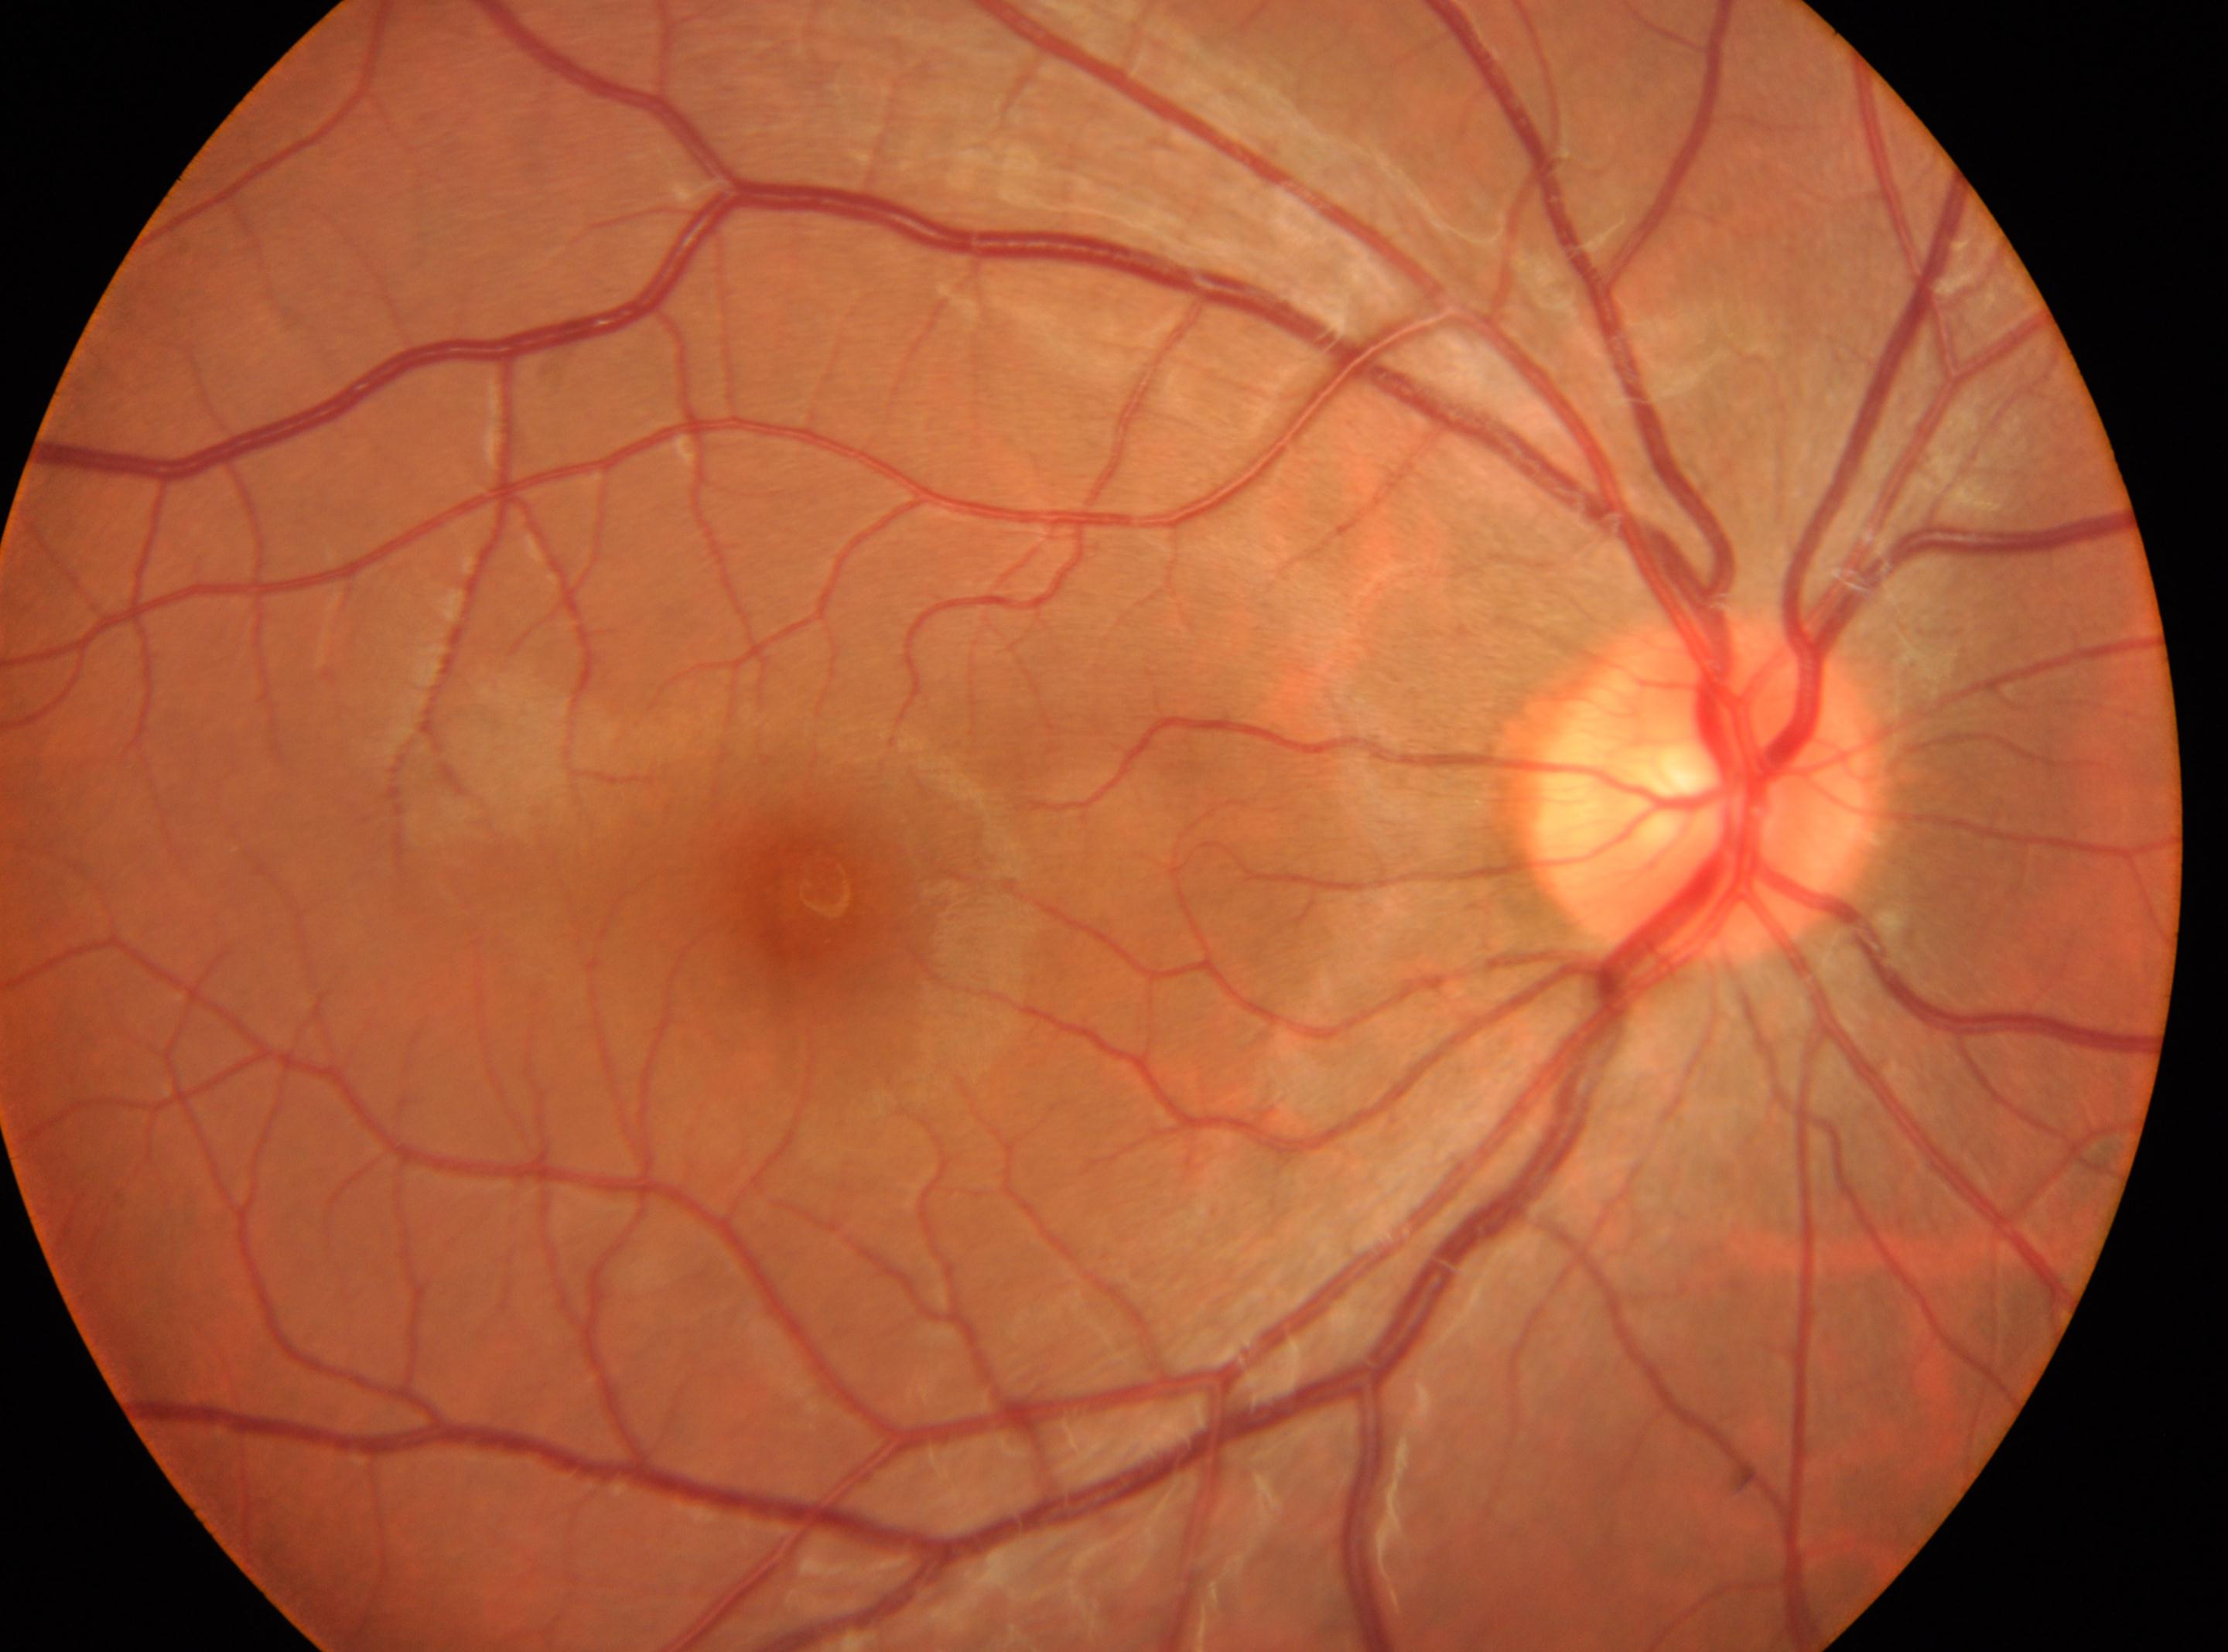 - eye: OD
- fovea centralis: [817, 894]
- retinopathy grade: 0 (no apparent retinopathy) — no visible signs of diabetic retinopathy
- optic disc center: [1703, 789]